45-degree field of view:
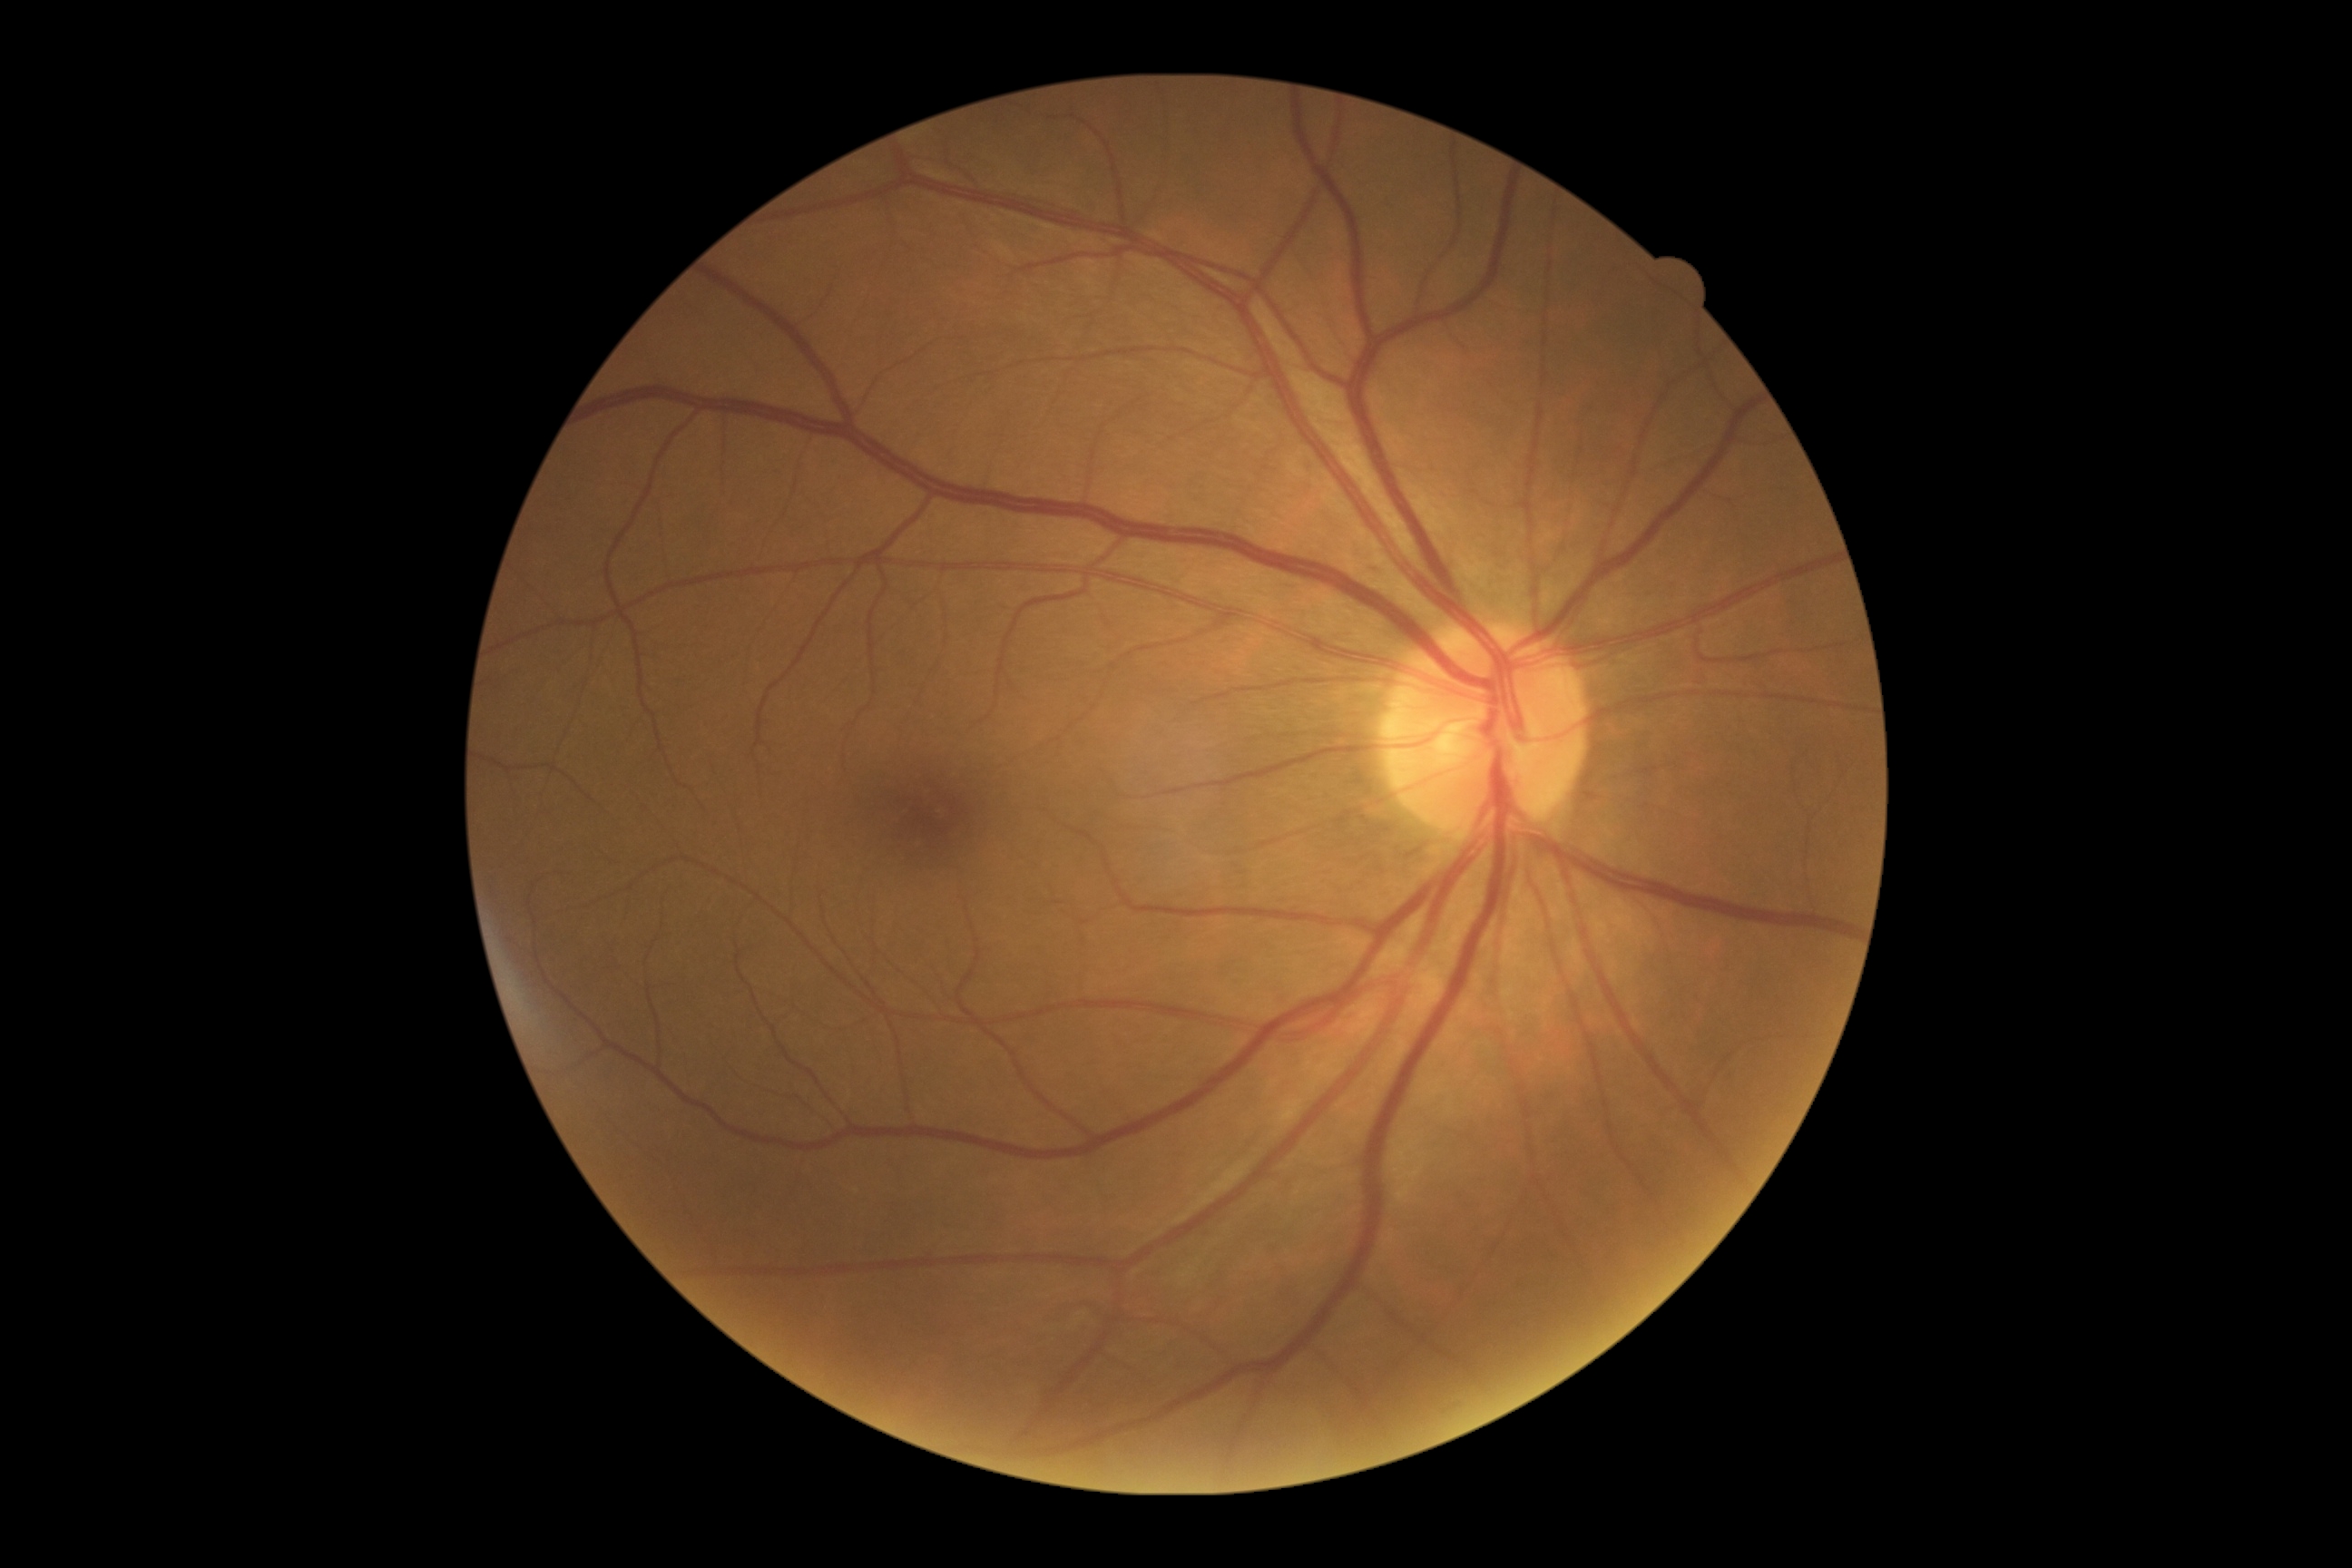 {
  "dr_grade": "grade 0"
}